2048x1536; 45° field of view — 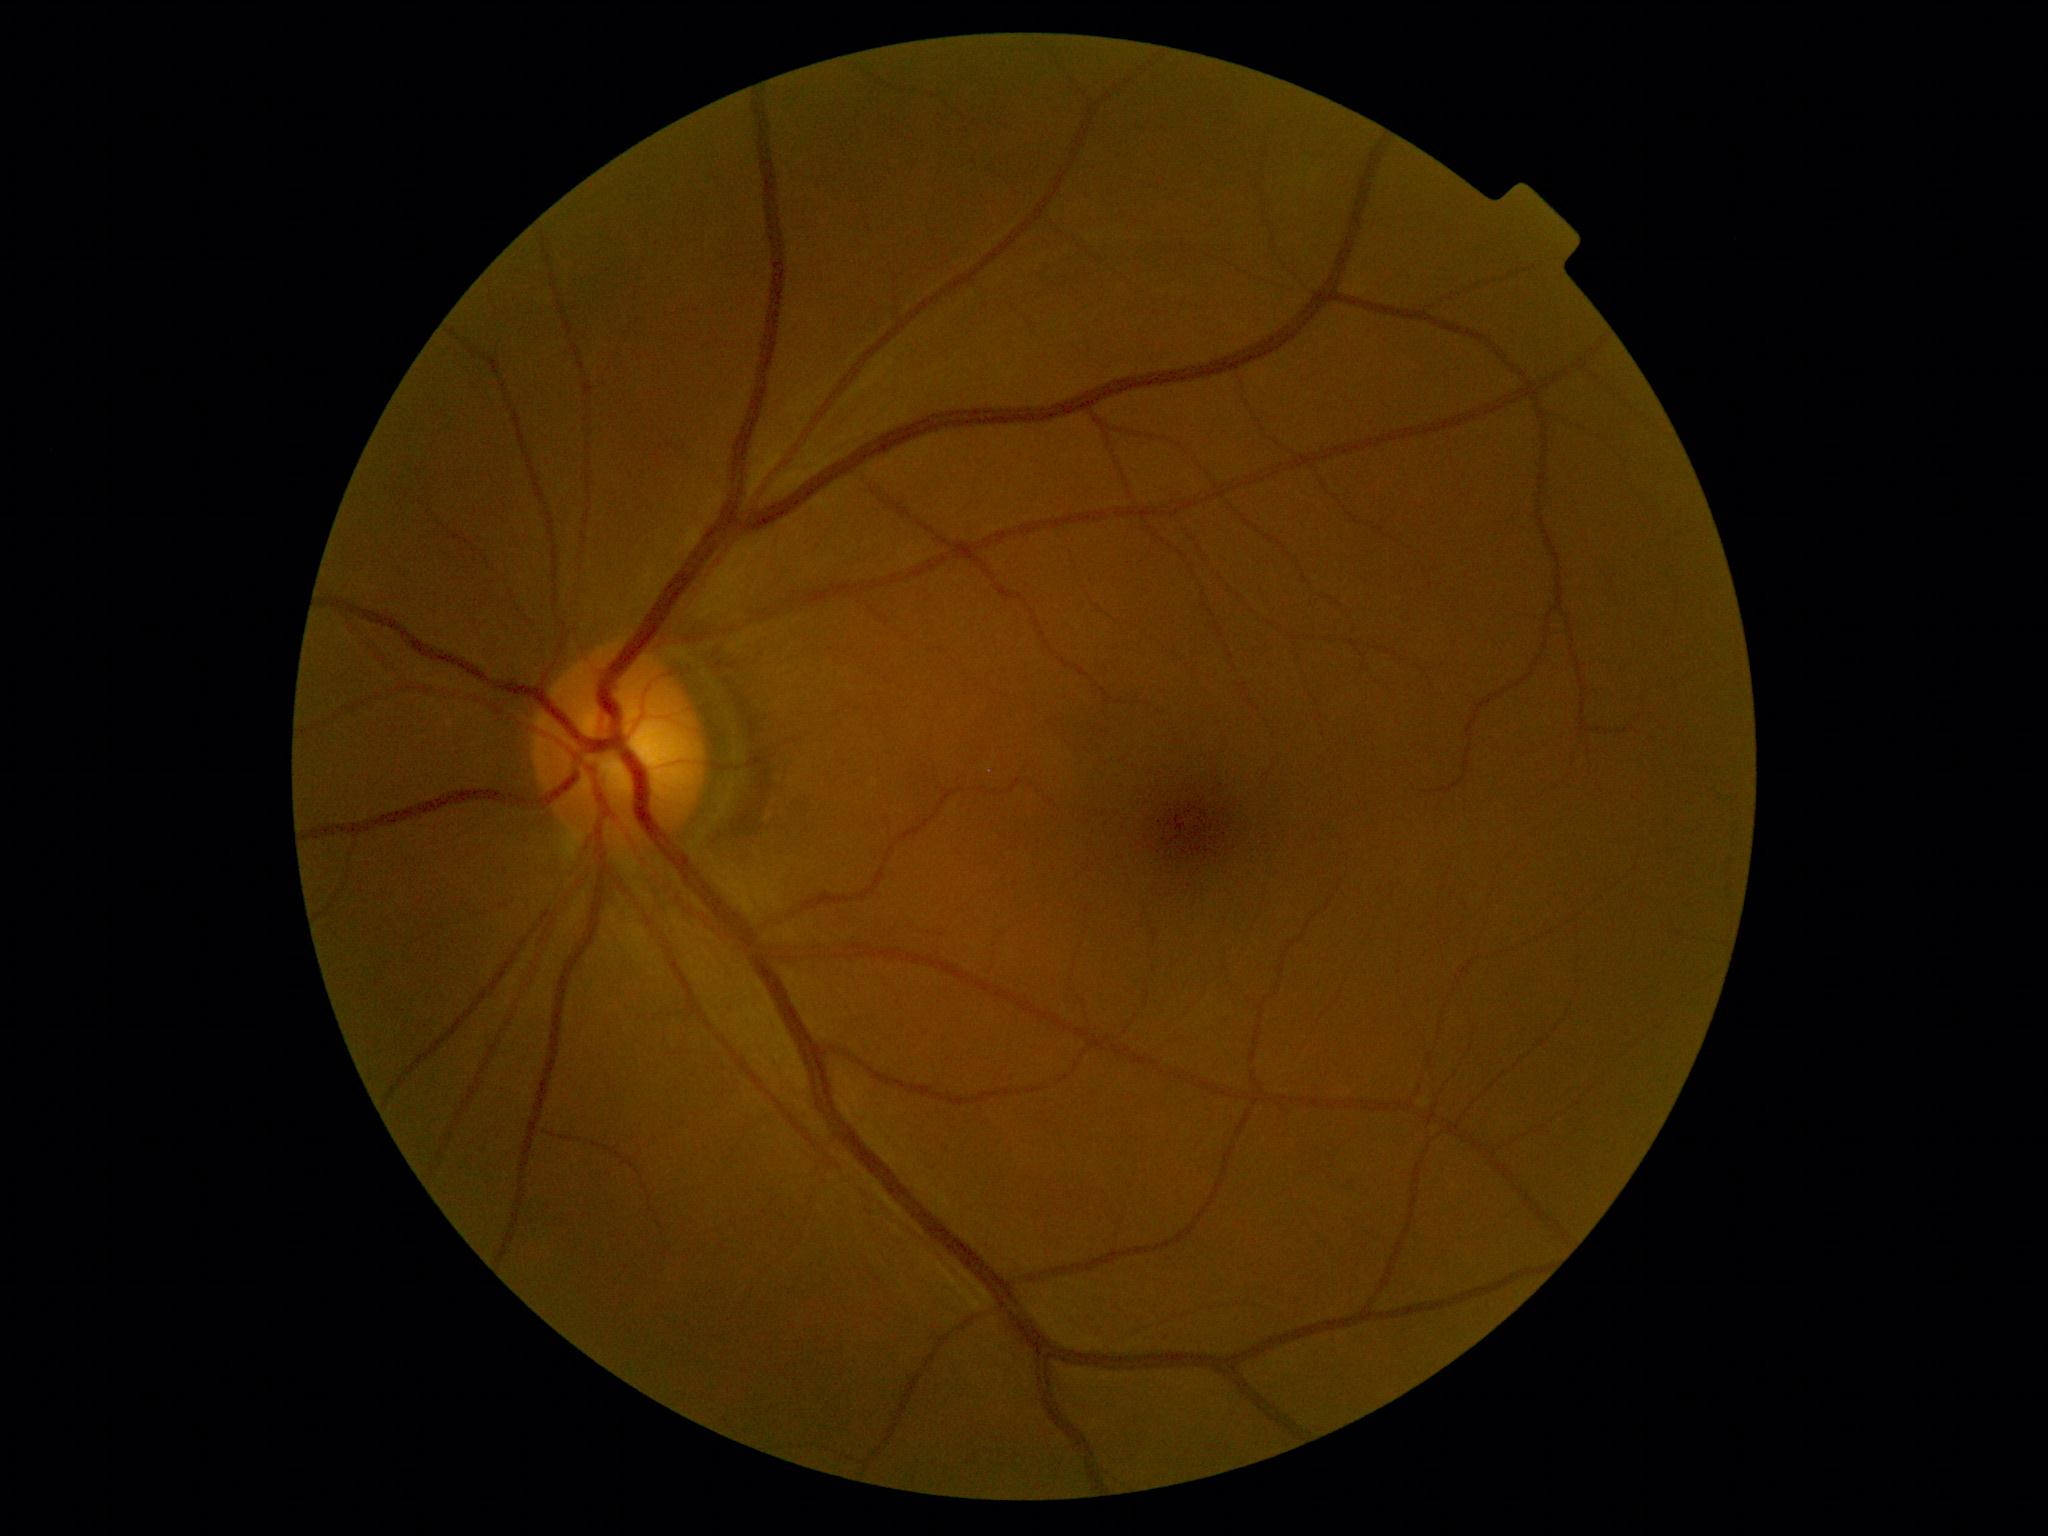 Diabetic retinopathy is grade 0 (no apparent retinopathy).